Davis DR grading.
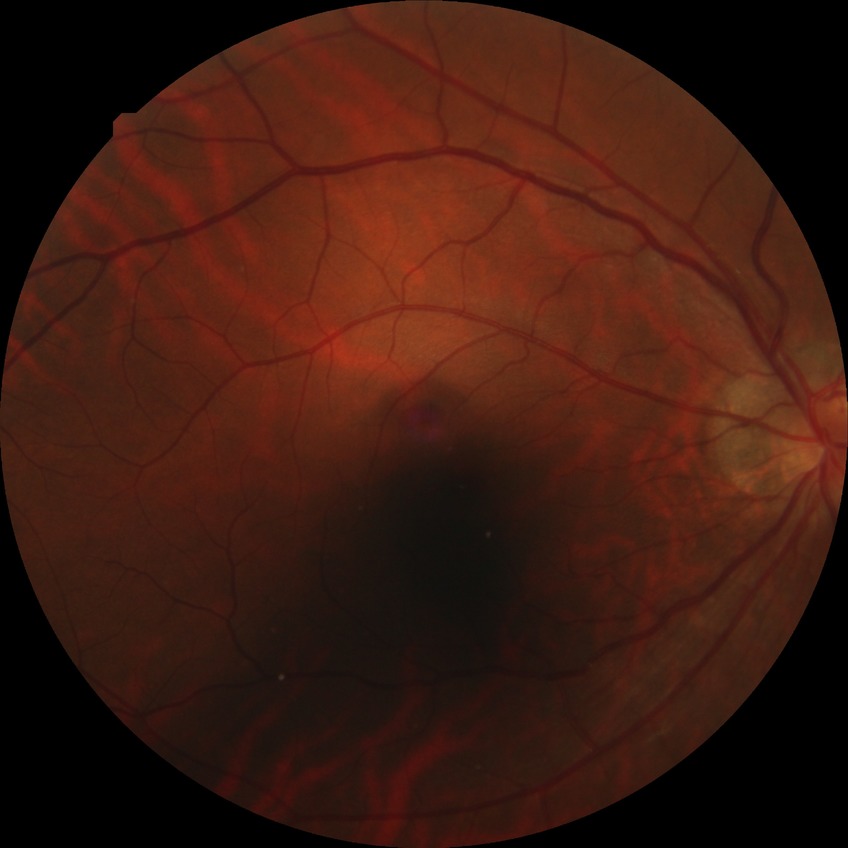 Diabetic retinopathy (DR): NDR (no diabetic retinopathy).